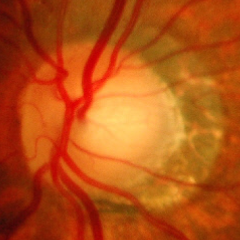
Optic disc appearance consistent with advanced-stage glaucoma.